Image size 2102x1736:
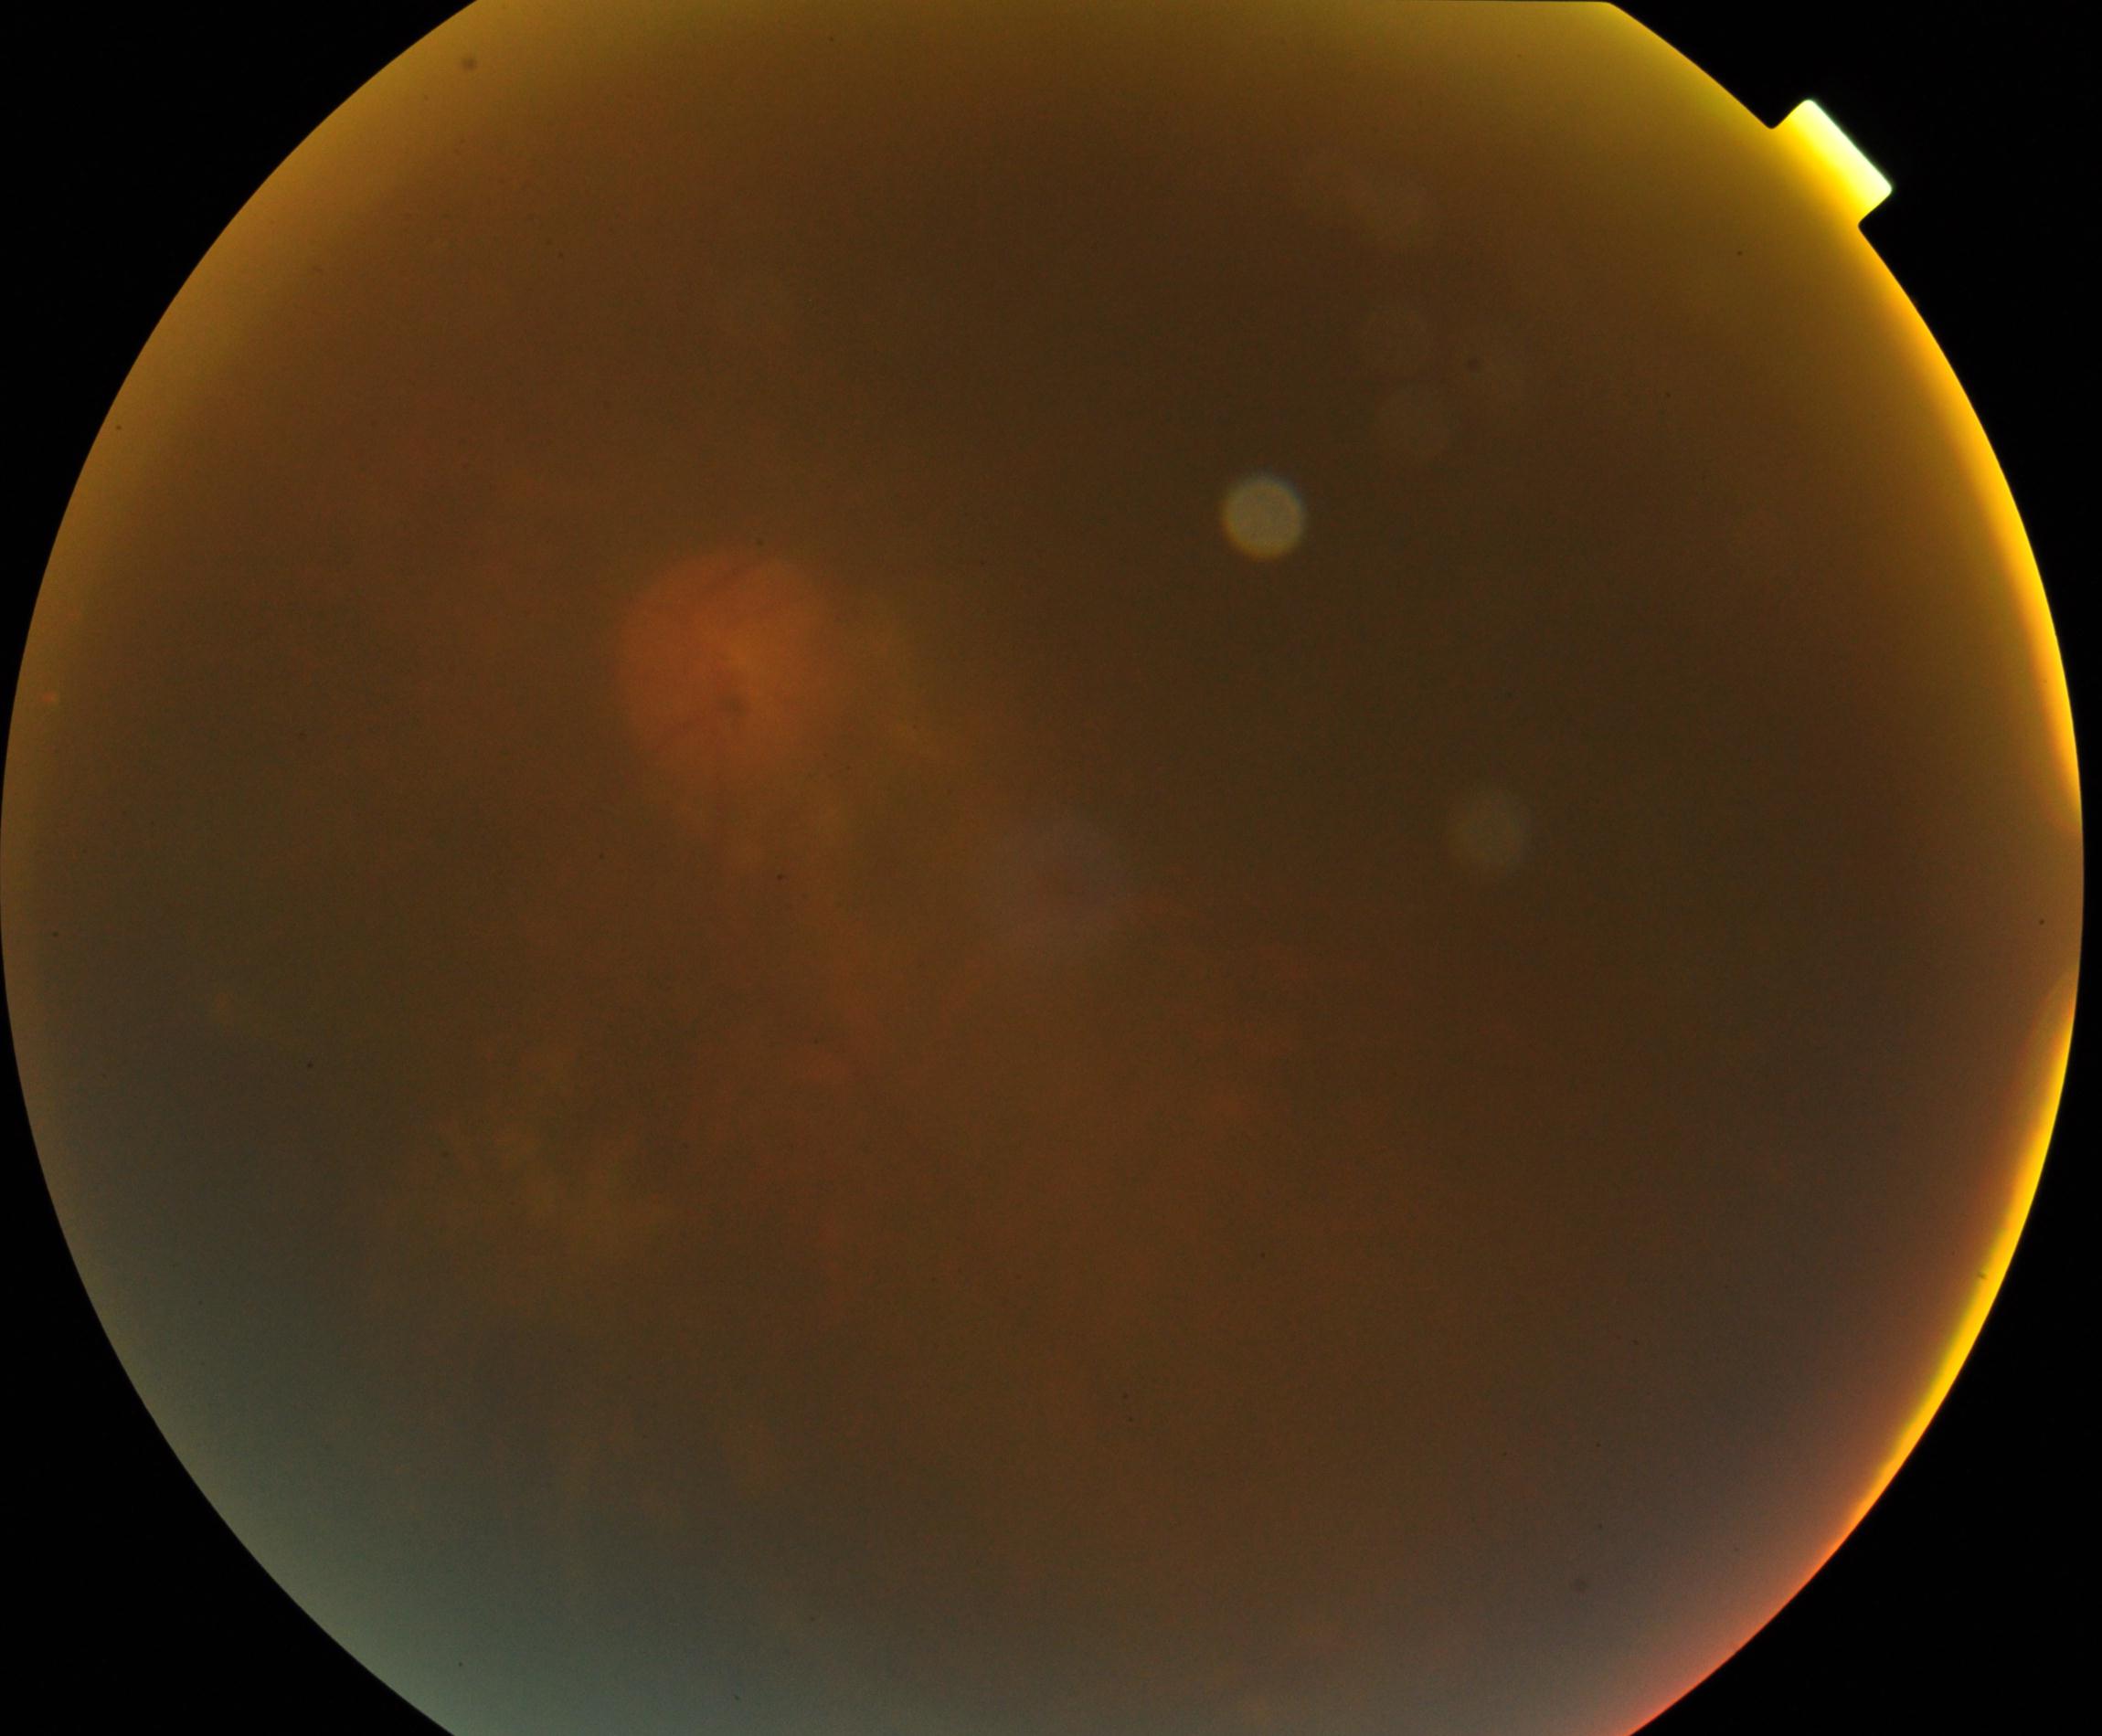 Significantly degraded image quality with obscured retinal detail. No proliferative diabetic retinopathy identified.